Color fundus image · nonmydriatic fundus photograph · image size 848x848 · diabetic retinopathy graded by the modified Davis classification · 45 degree fundus photograph.
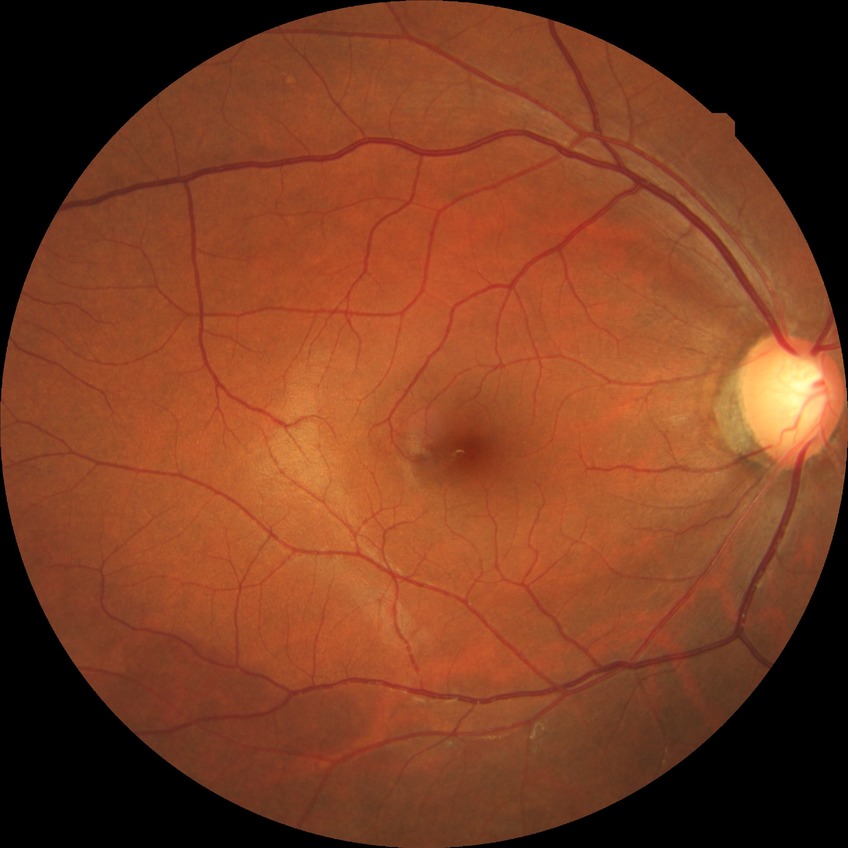
Assessment:
- Davis DR grade — NDR